Wide-field fundus image from infant ROP screening · captured with the Clarity RetCam 3 (130° field of view) — 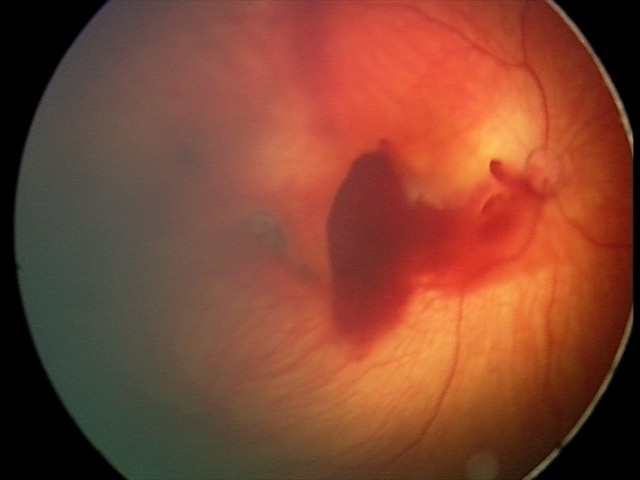 Diagnosis from this screening exam: retinal hemorrhages.